1659x2212: 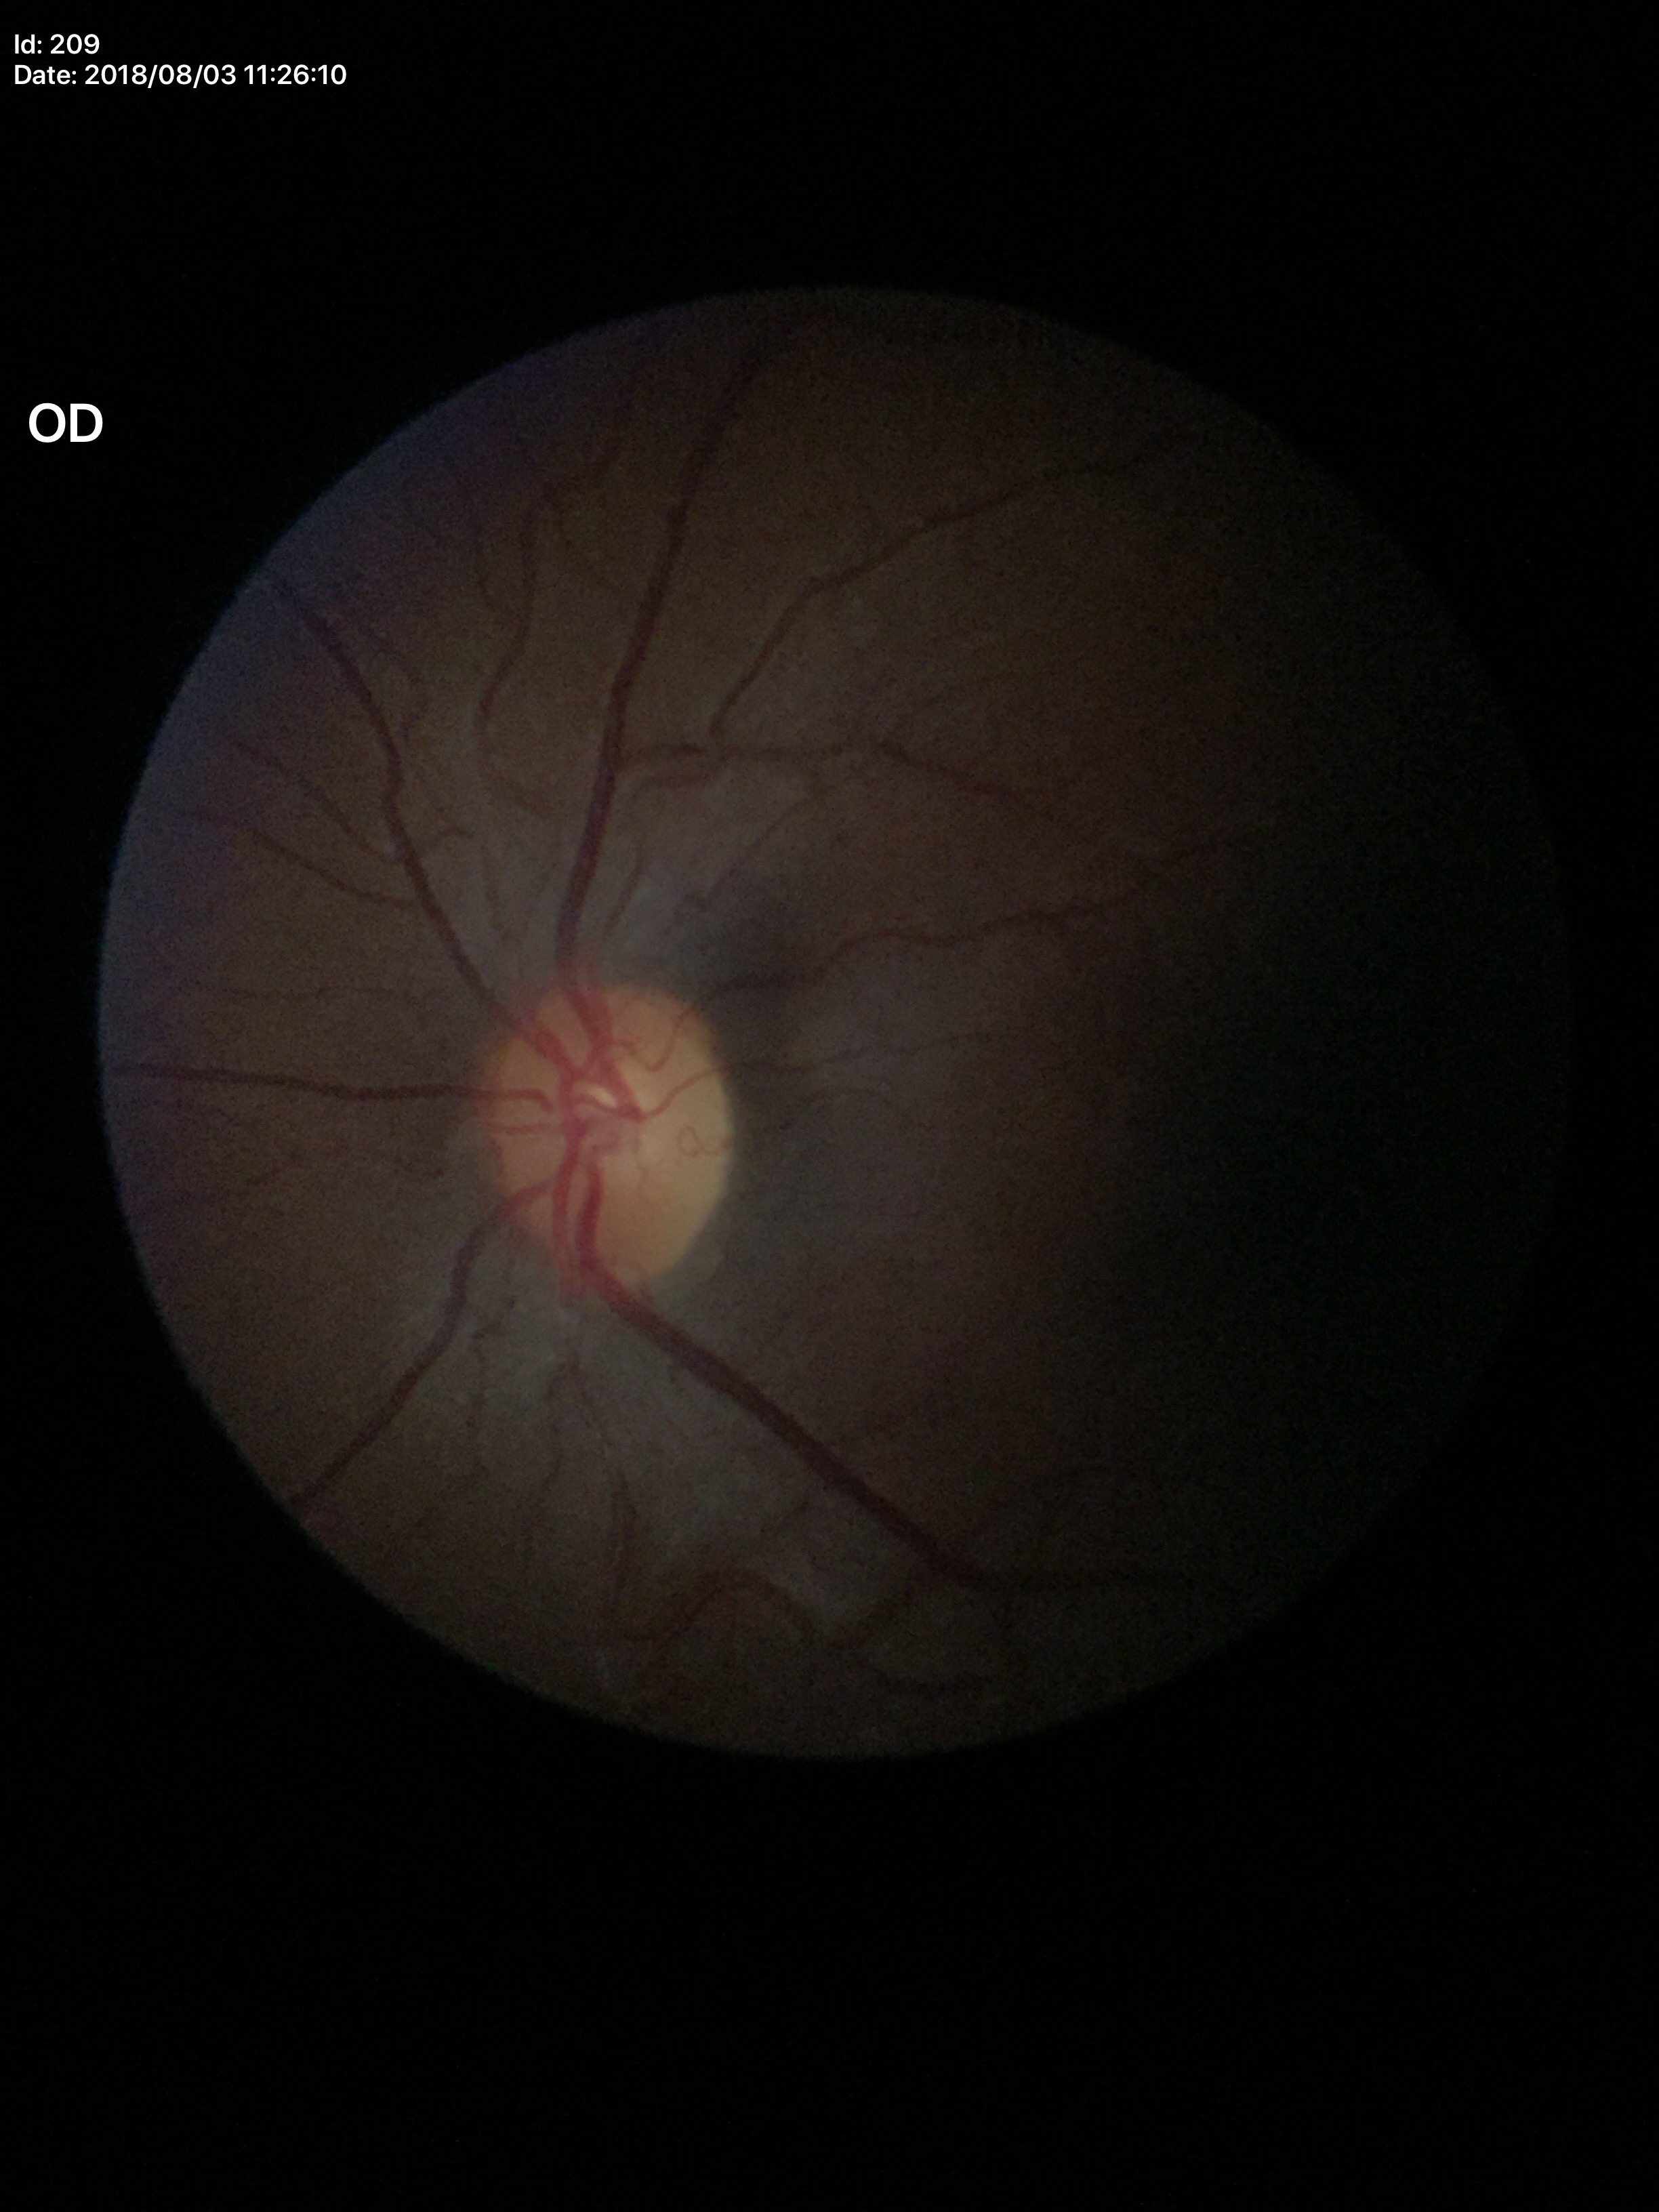
Glaucoma decision: negative (5/5 ophthalmologists in agreement)
vertical cup-disc ratio (VCDR): 0.45
horizontal cup-disc ratio (HCDR): 0.41